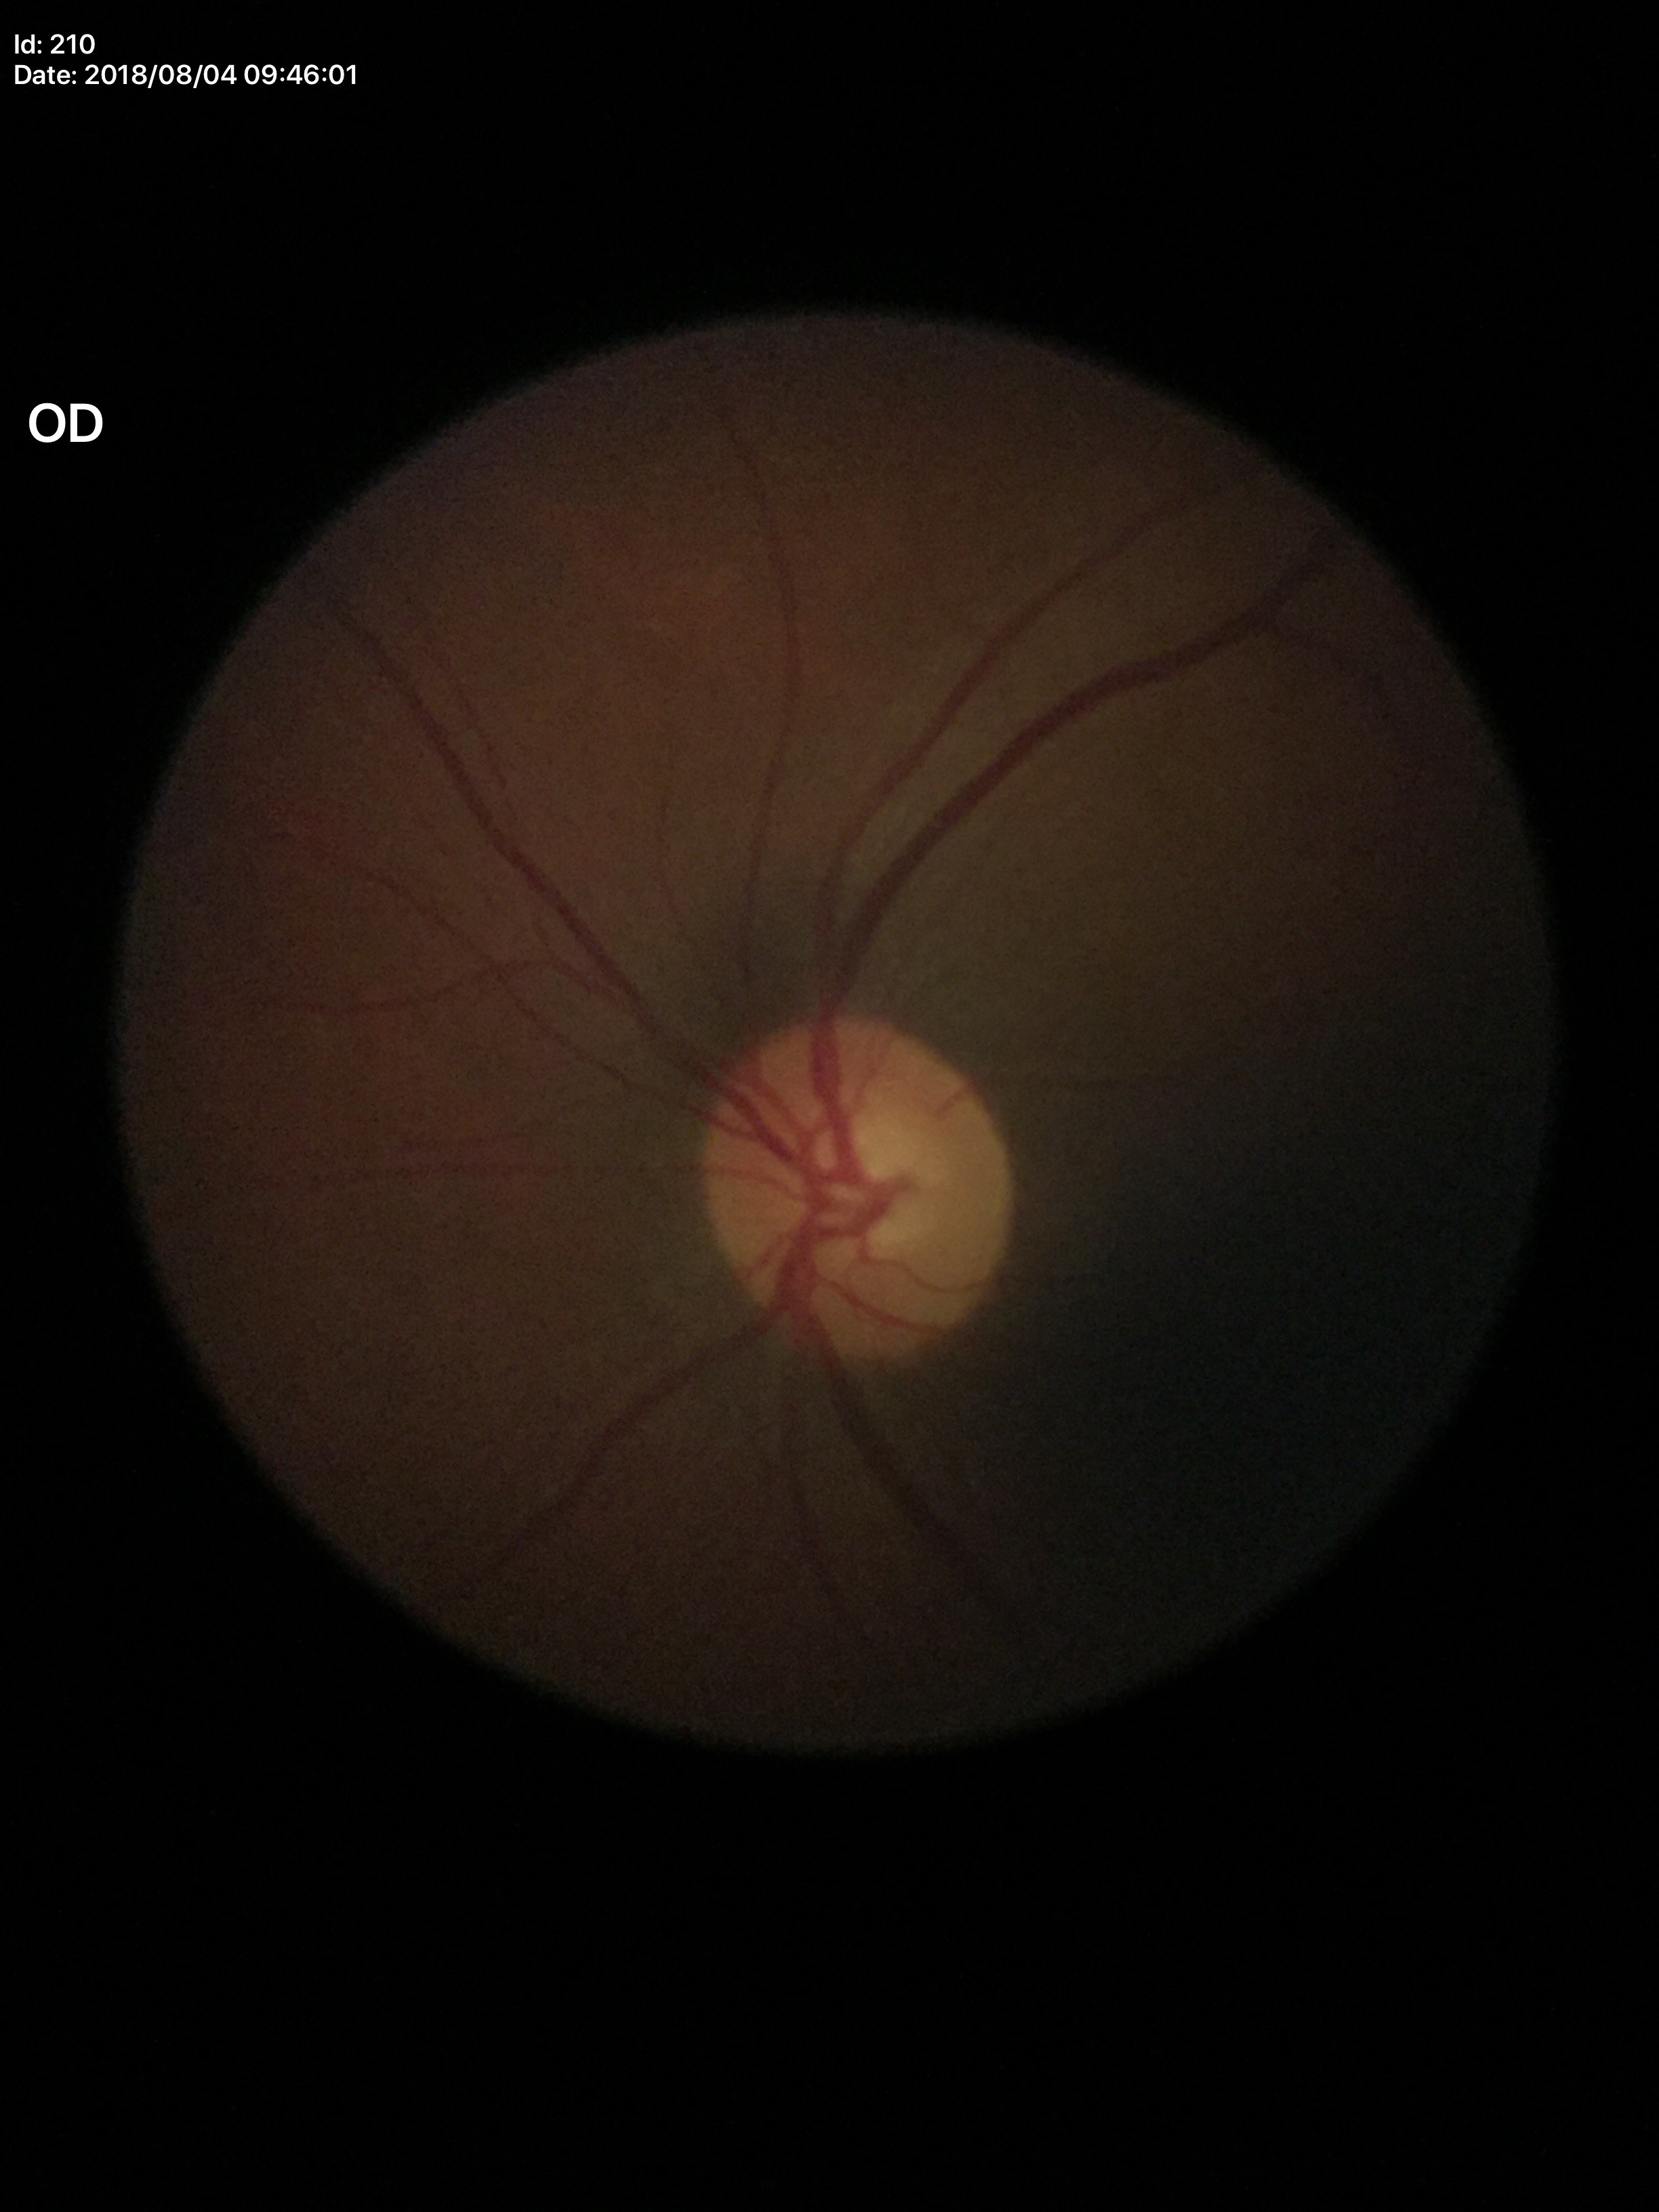 Q: What is the glaucoma assessment?
A: not suspect (1/5 graders called glaucoma suspect)
Q: Horizontal CDR?
A: 0.58
Q: Vertical CDR?
A: 0.52